640 by 480 pixels. Wide-field contact fundus photograph of an infant
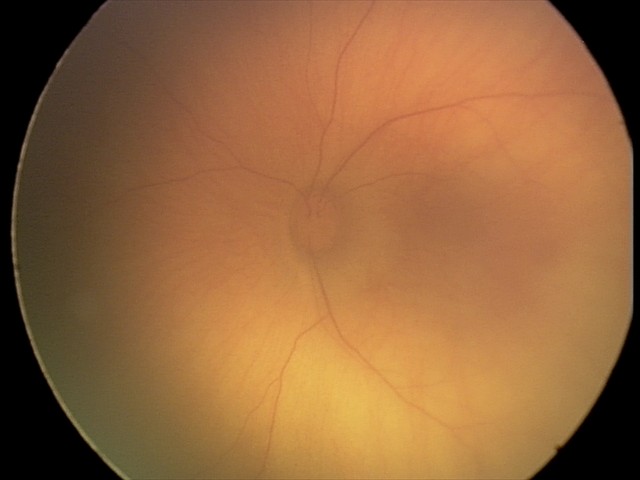

Series diagnosed as retinal hemorrhages.